Without pupil dilation, Davis DR grading, NIDEK AFC-230 — 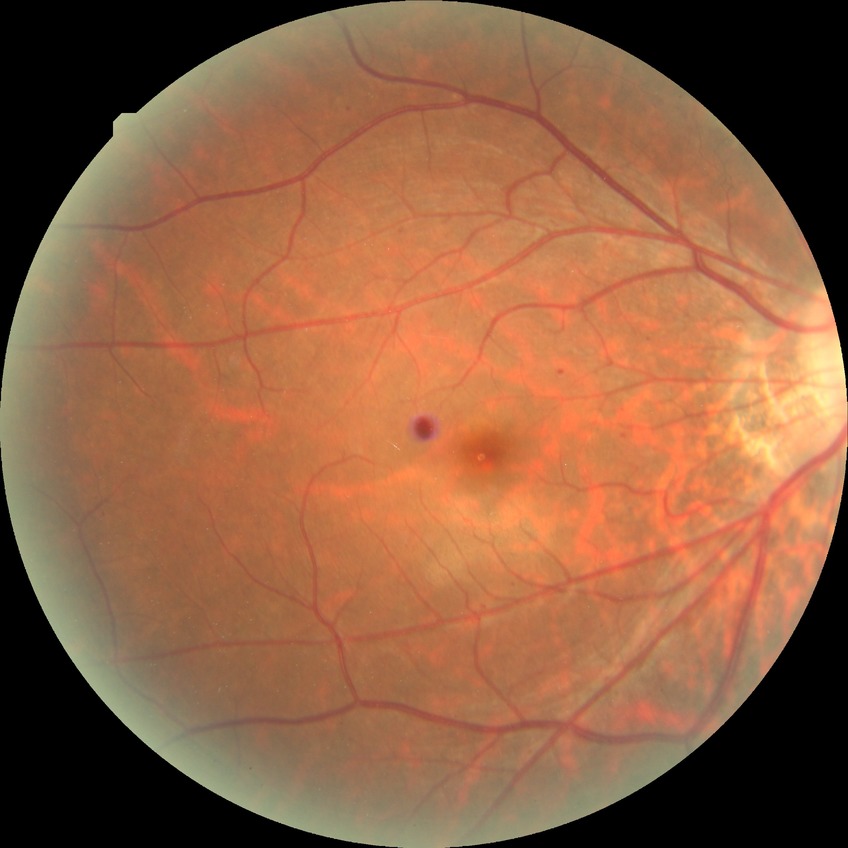

Diabetic retinopathy severity is simple diabetic retinopathy.